FOV: 45 degrees; 2352x1568px; fundus photo
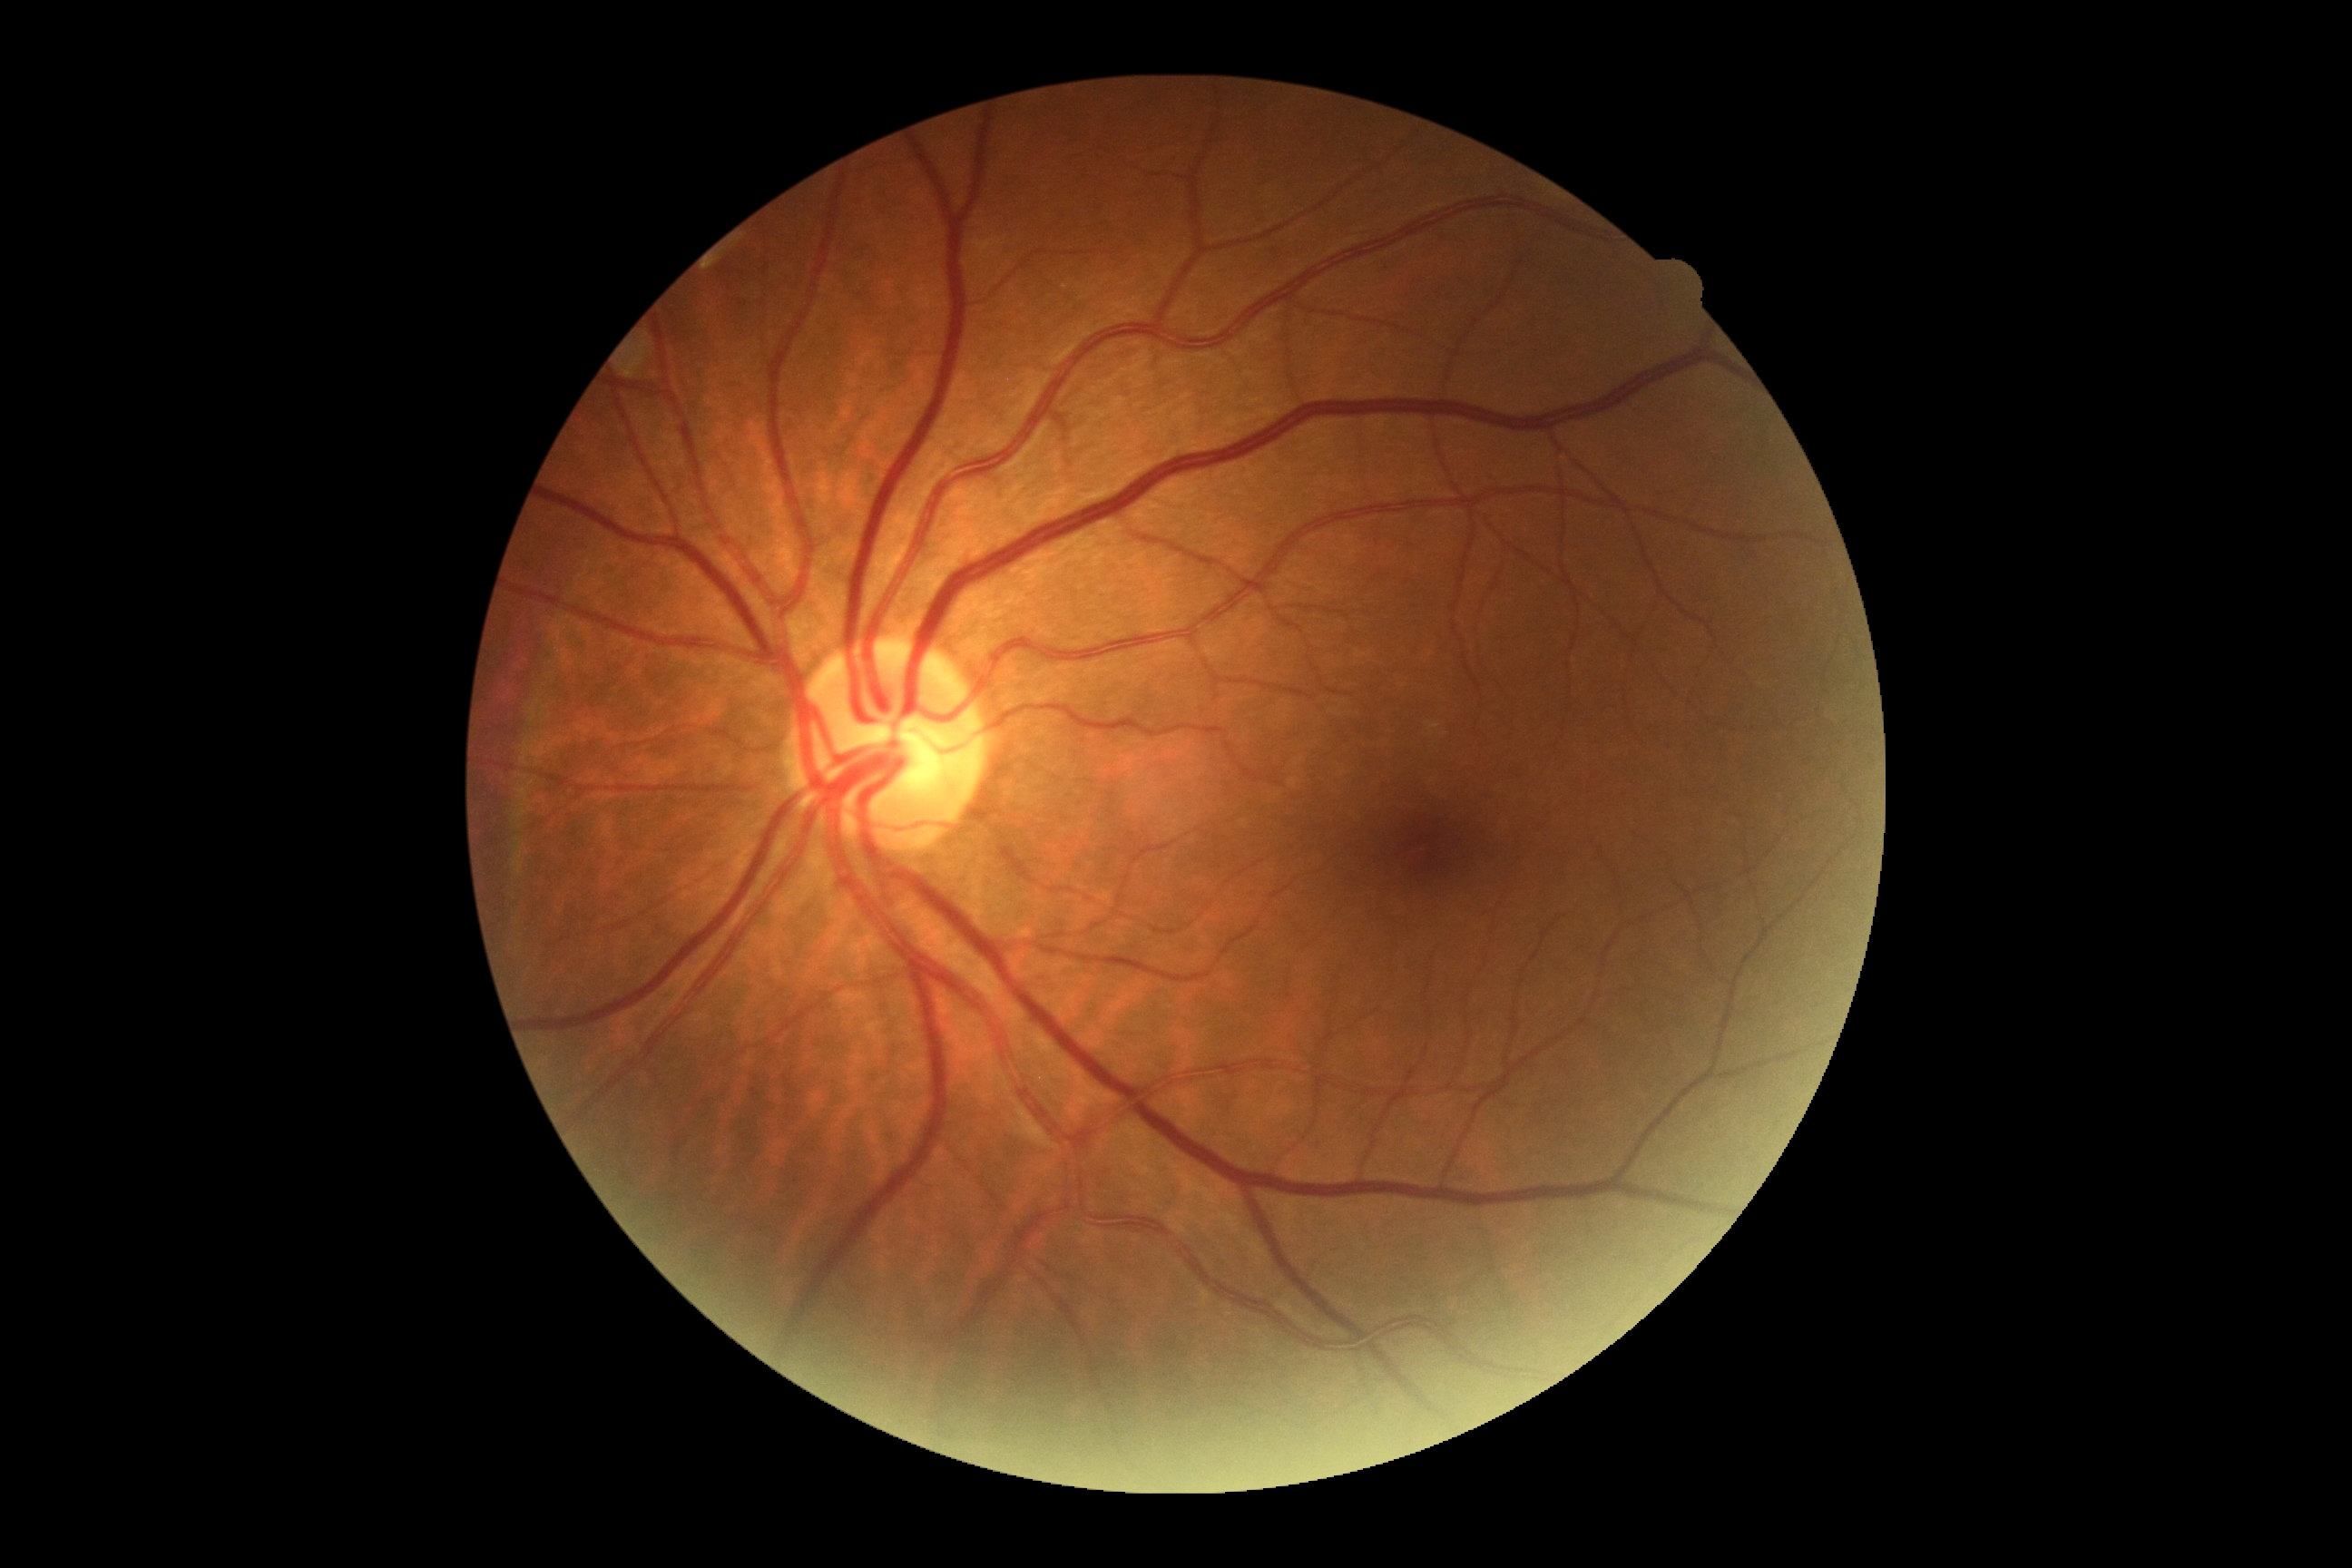 DR is no apparent retinopathy (grade 0).